45 degree fundus photograph — 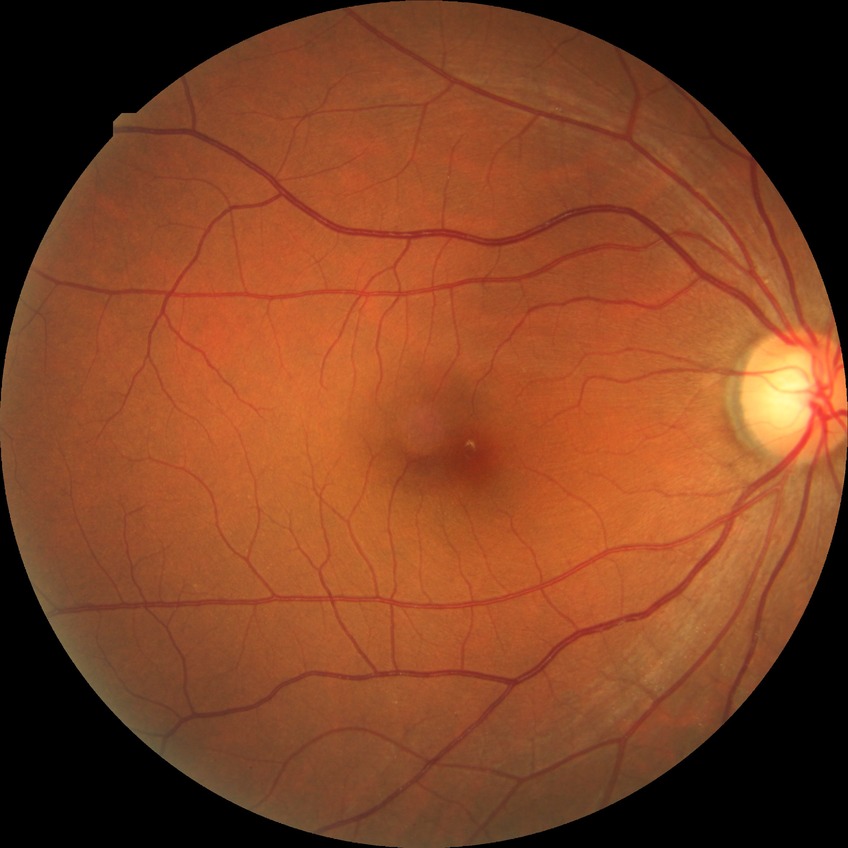
Retinopathy grade: no diabetic retinopathy.